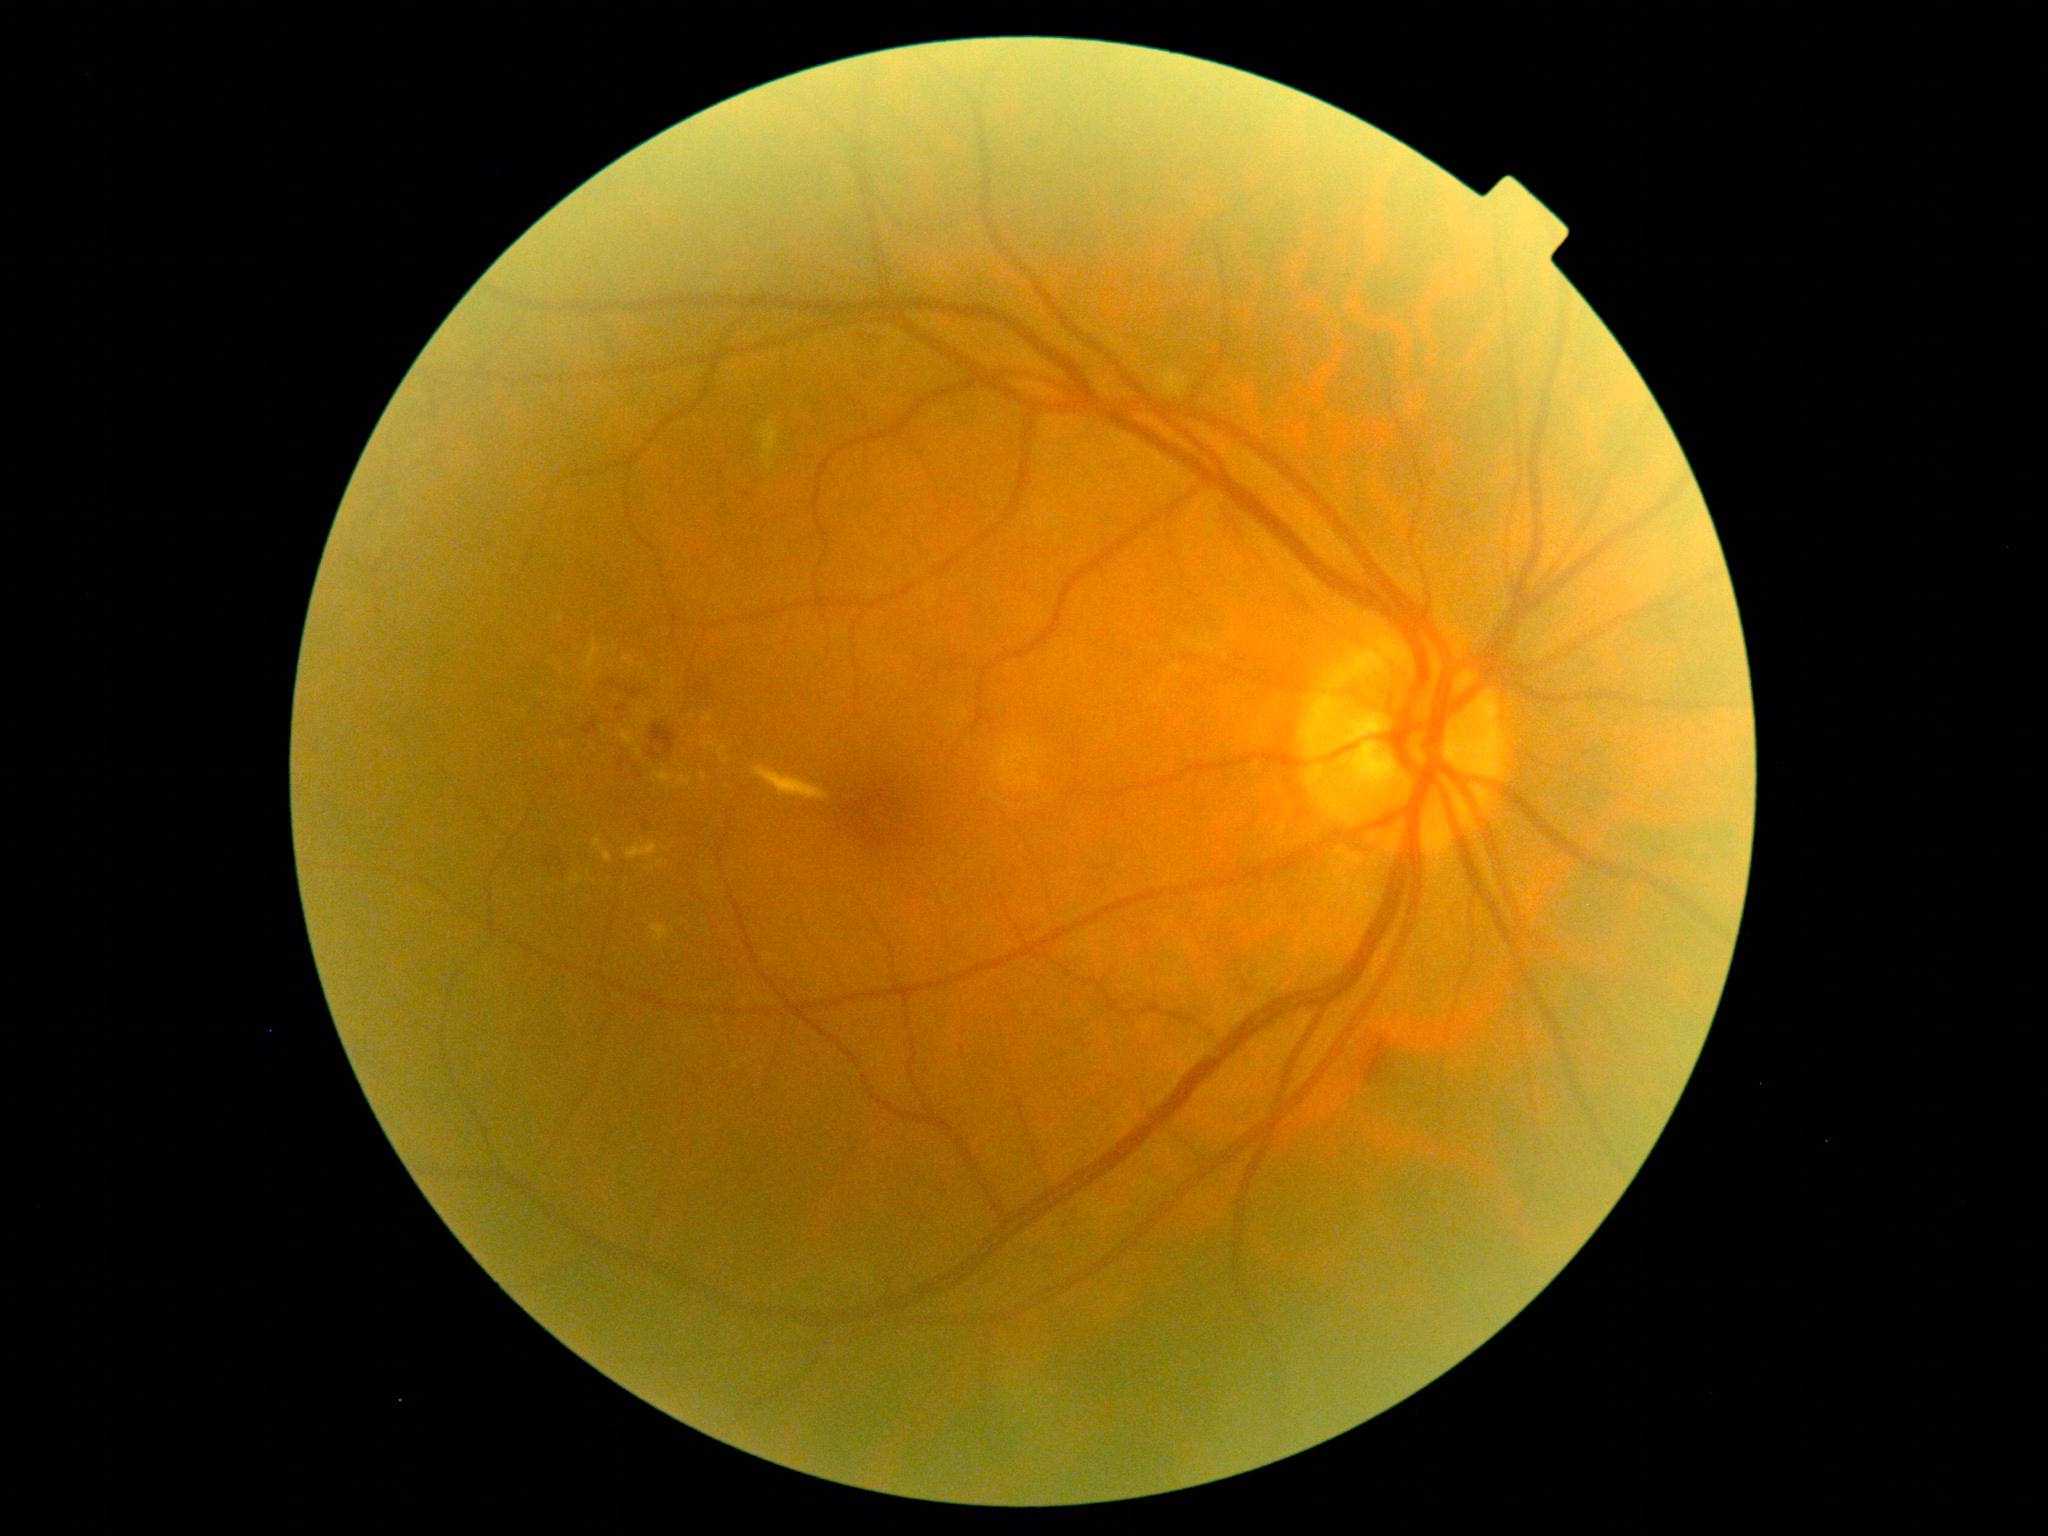 DR severity: grade 2; non-proliferative diabetic retinopathy
Lesions identified (partial list):
• EXs (partial): left=622, top=658, right=632, bottom=662 | left=594, top=836, right=612, bottom=863 | left=753, top=766, right=830, bottom=801 | left=719, top=745, right=729, bottom=764 | left=703, top=712, right=713, bottom=723 | left=706, top=872, right=713, bottom=882 | left=653, top=771, right=677, bottom=784 | left=562, top=743, right=566, bottom=751
• EXs (small, approximate centers) near point(599, 674) | point(648, 678) | point(659, 947) | point(669, 788) | point(665, 849) | point(640, 711) | point(709, 934)
• HEs (partial): left=651, top=724, right=678, bottom=756 | left=562, top=869, right=568, bottom=880 | left=609, top=679, right=624, bottom=691 | left=618, top=758, right=625, bottom=768 | left=543, top=859, right=566, bottom=873 | left=687, top=683, right=713, bottom=694 | left=627, top=688, right=642, bottom=698 | left=617, top=705, right=627, bottom=714 | left=1363, top=1038, right=1390, bottom=1085 | left=648, top=747, right=660, bottom=759 | left=582, top=720, right=599, bottom=737
• HEs (small, approximate centers) near point(605, 685) | point(564, 776) | point(638, 778) | point(628, 778) | point(559, 848) | point(690, 682)
• SEs: left=757, top=421, right=782, bottom=472 | left=1158, top=367, right=1190, bottom=398